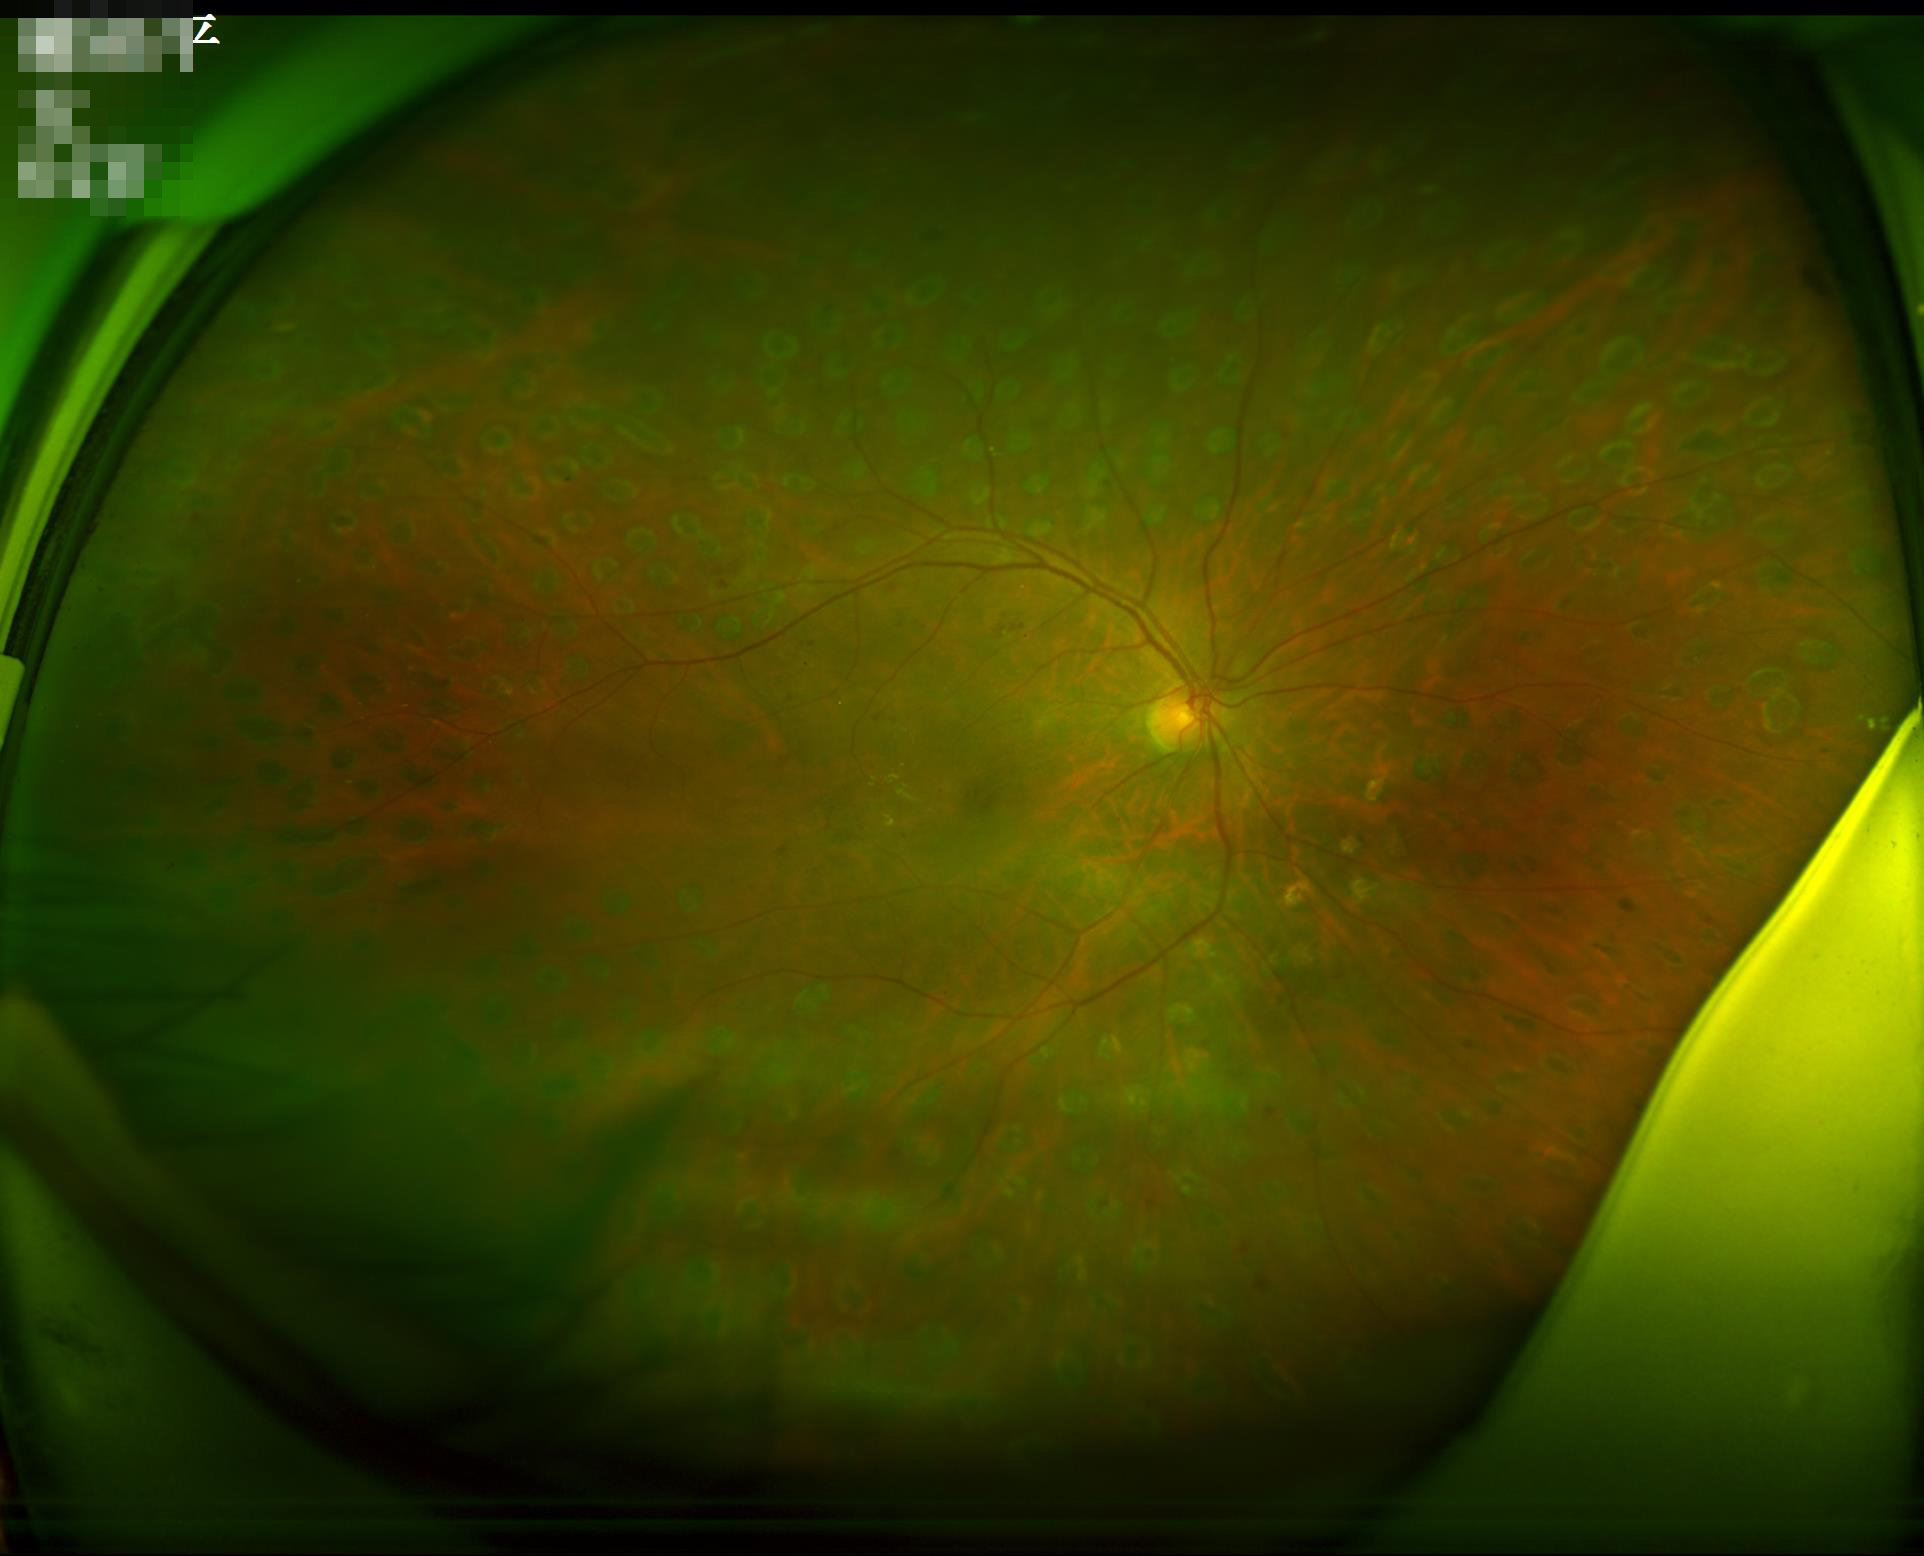
Out of focus; structures are indistinct.
Illumination is even.
Acceptable image quality.
Contrast is good.